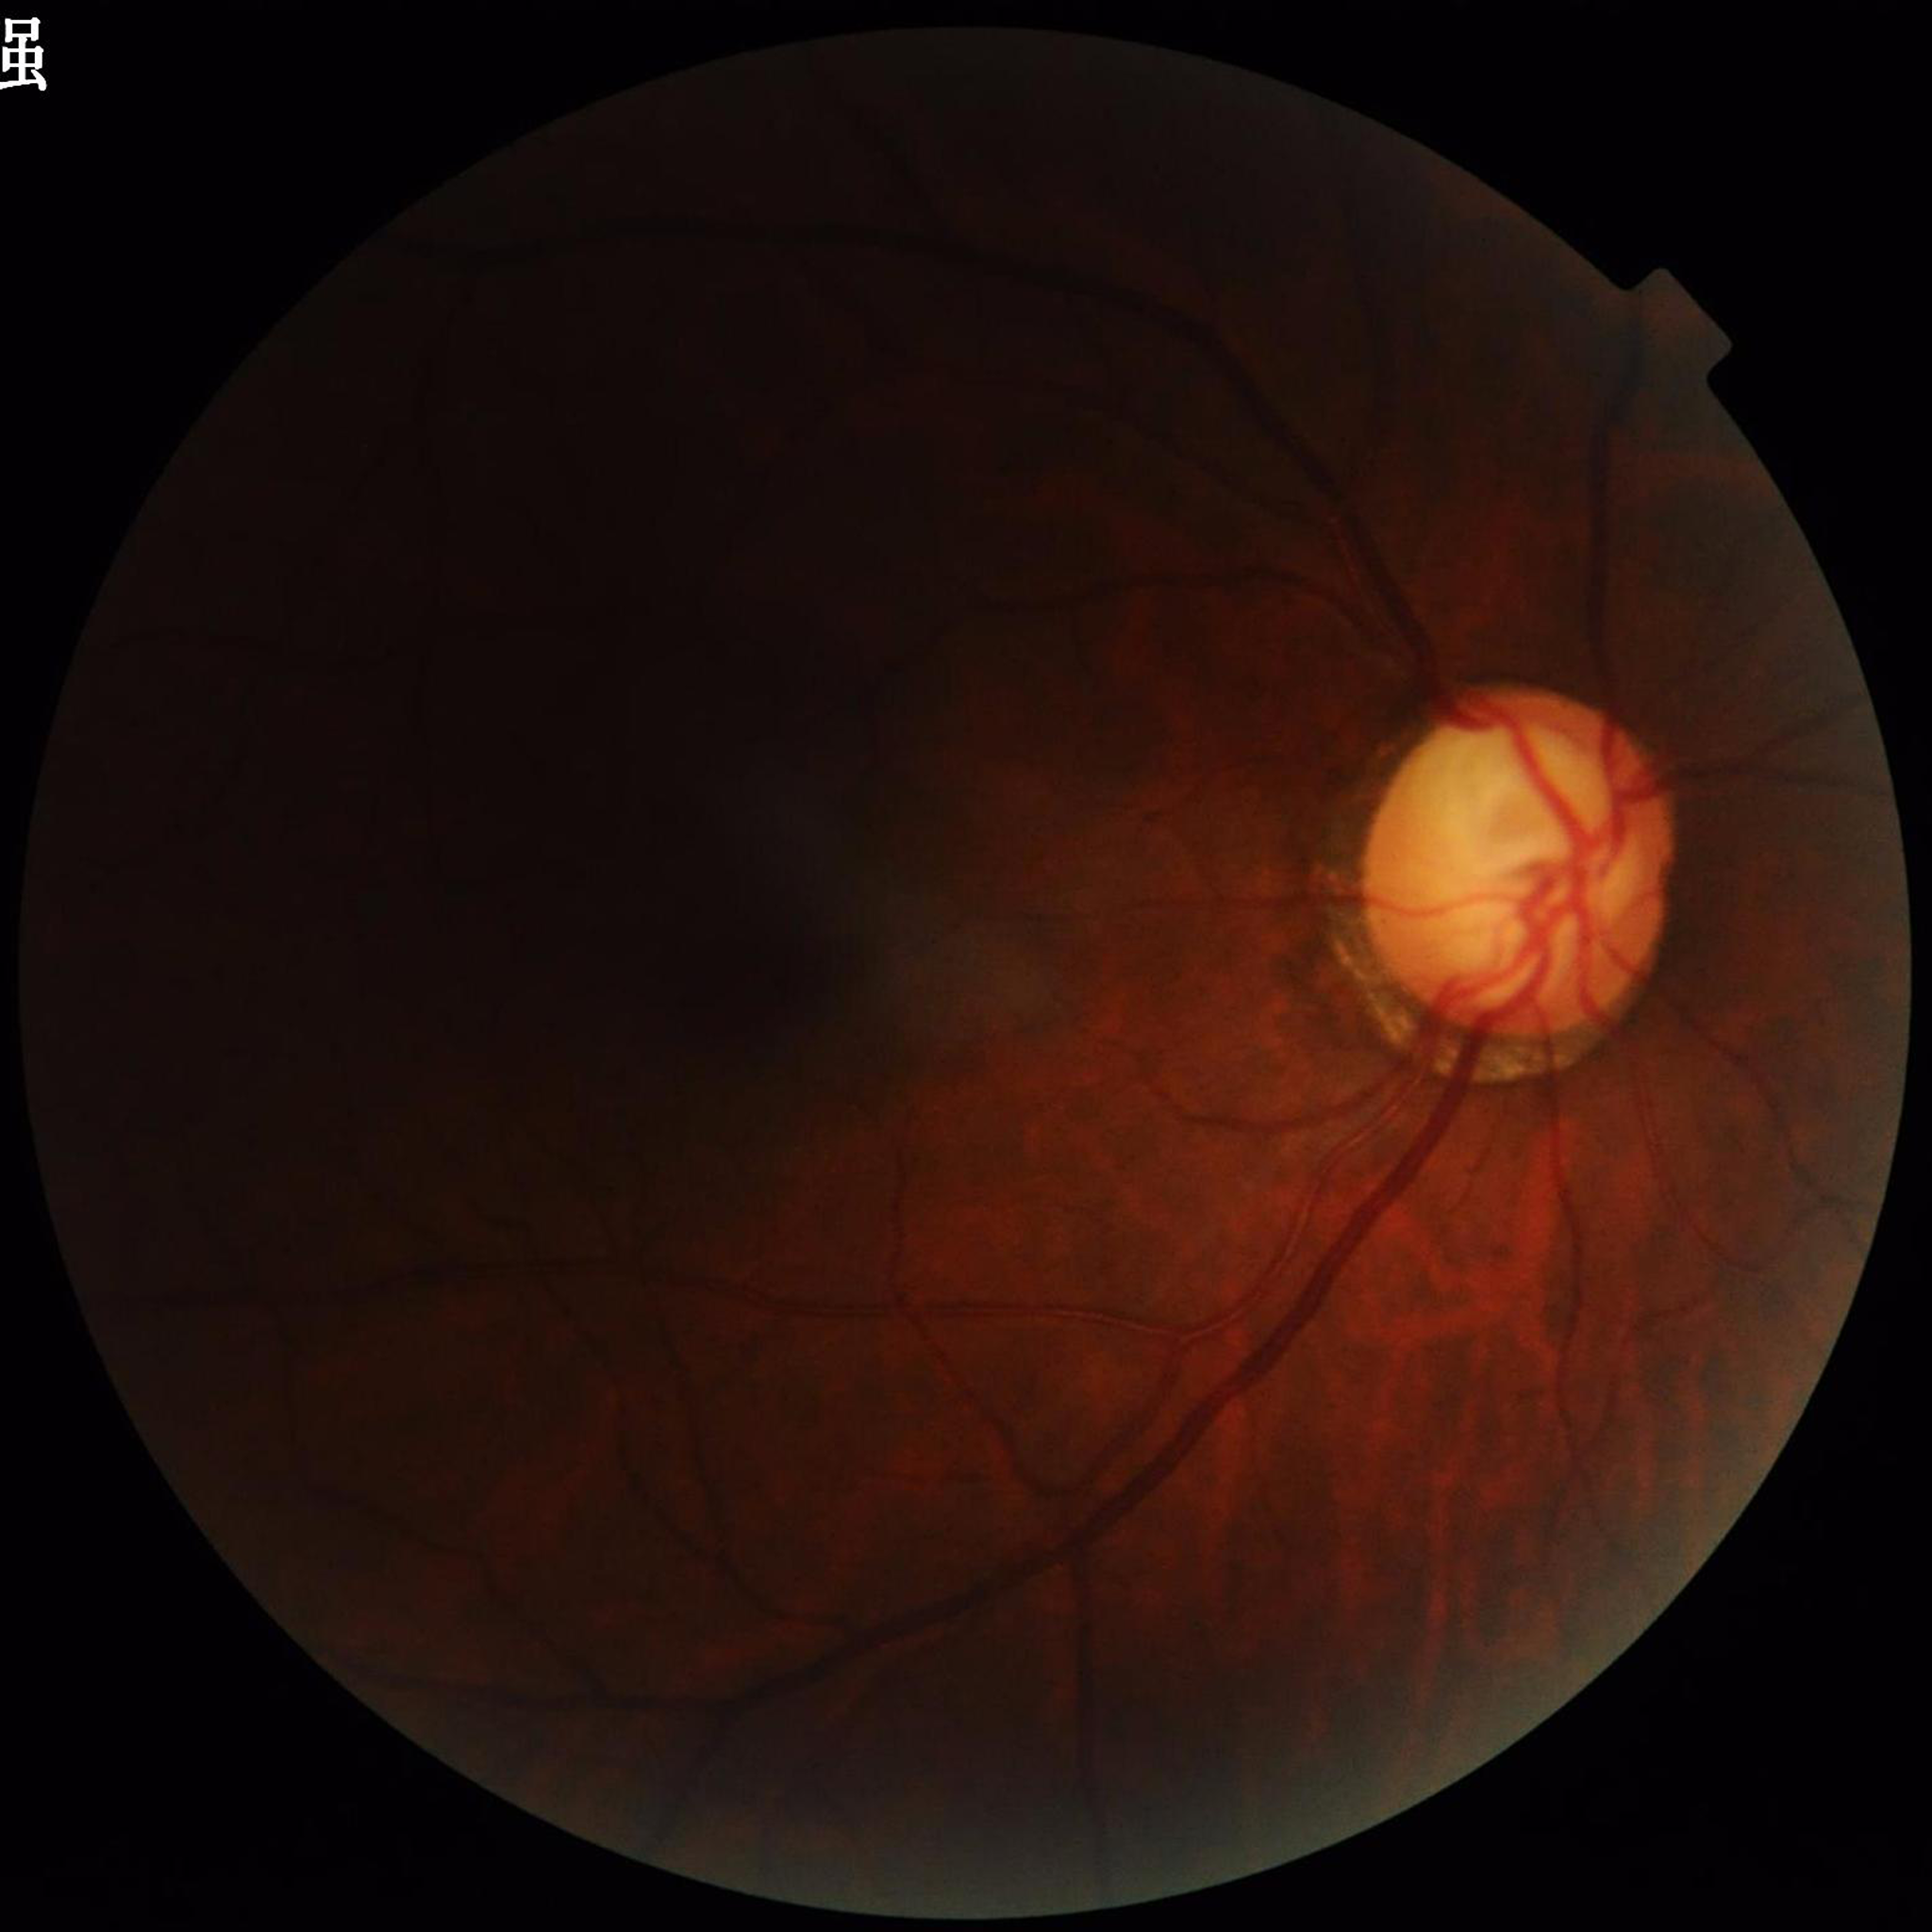 Automated quality assessment: issues noted — illumination/color distortion, blur; Disease class: glaucoma.